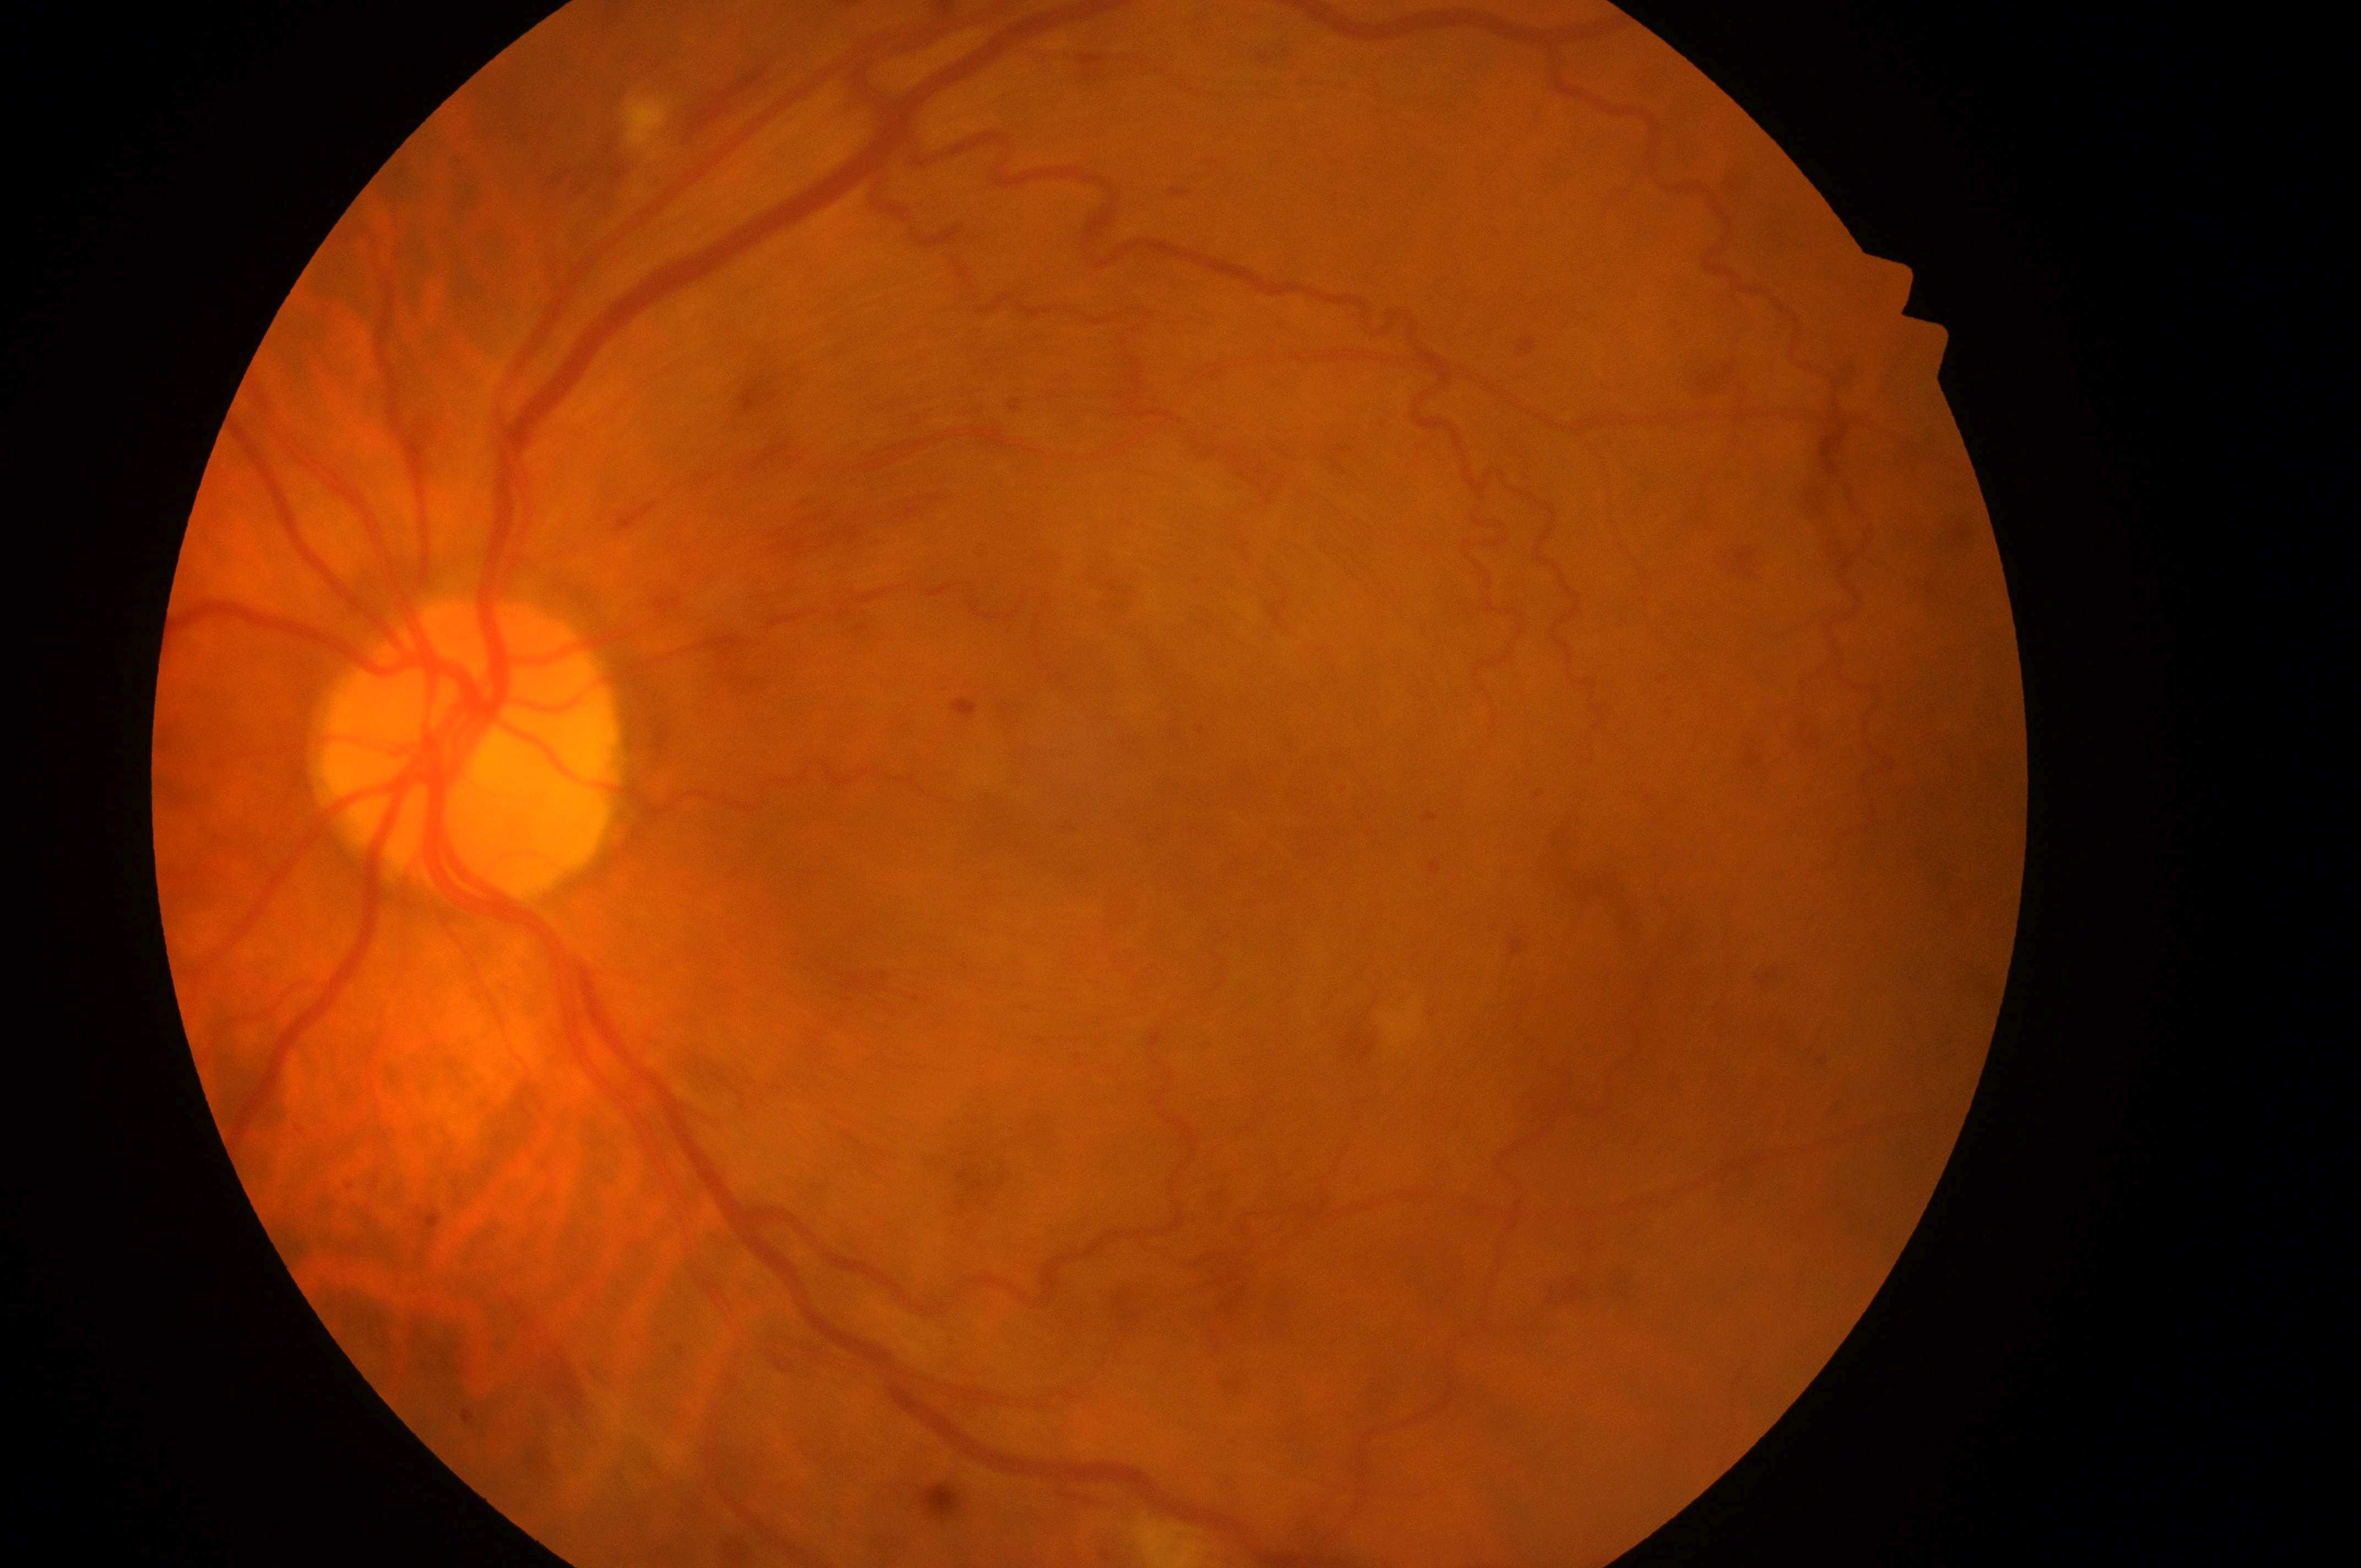

The foveal center is at 1275, 829. Eye: oculus sinister. DR severity: severe non-proliferative diabetic retinopathy (grade 3). DR class: non-proliferative diabetic retinopathy. DME risk: no risk (grade 0). Optic disc center located at 464, 756.